Modified Davis classification.
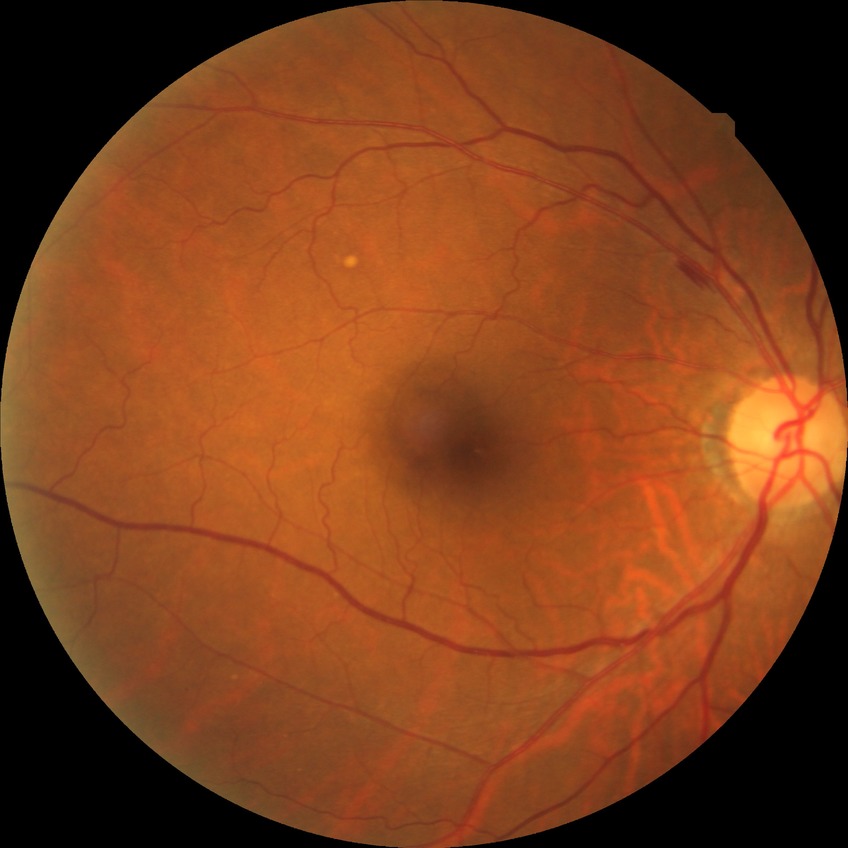 Diabetic retinopathy (DR) is NDR (no diabetic retinopathy).